45 degree fundus photograph. Color fundus image. 848x848px. Nonmydriatic fundus photograph — 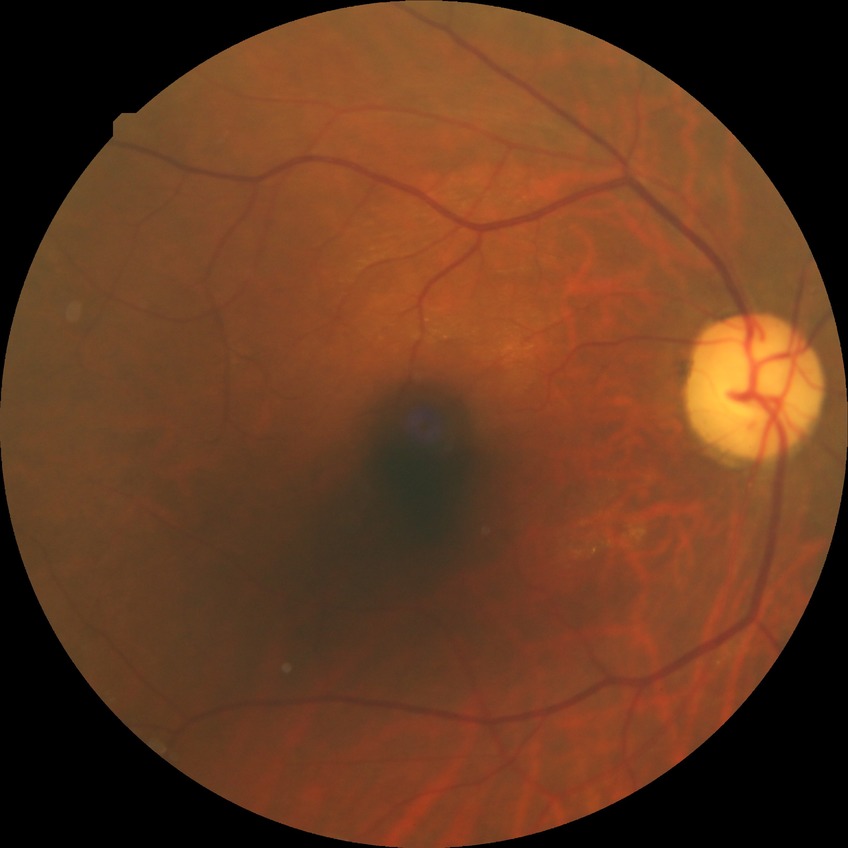 DR stage: NDR.